Pupil-dilated; 2228 x 1652 pixels:
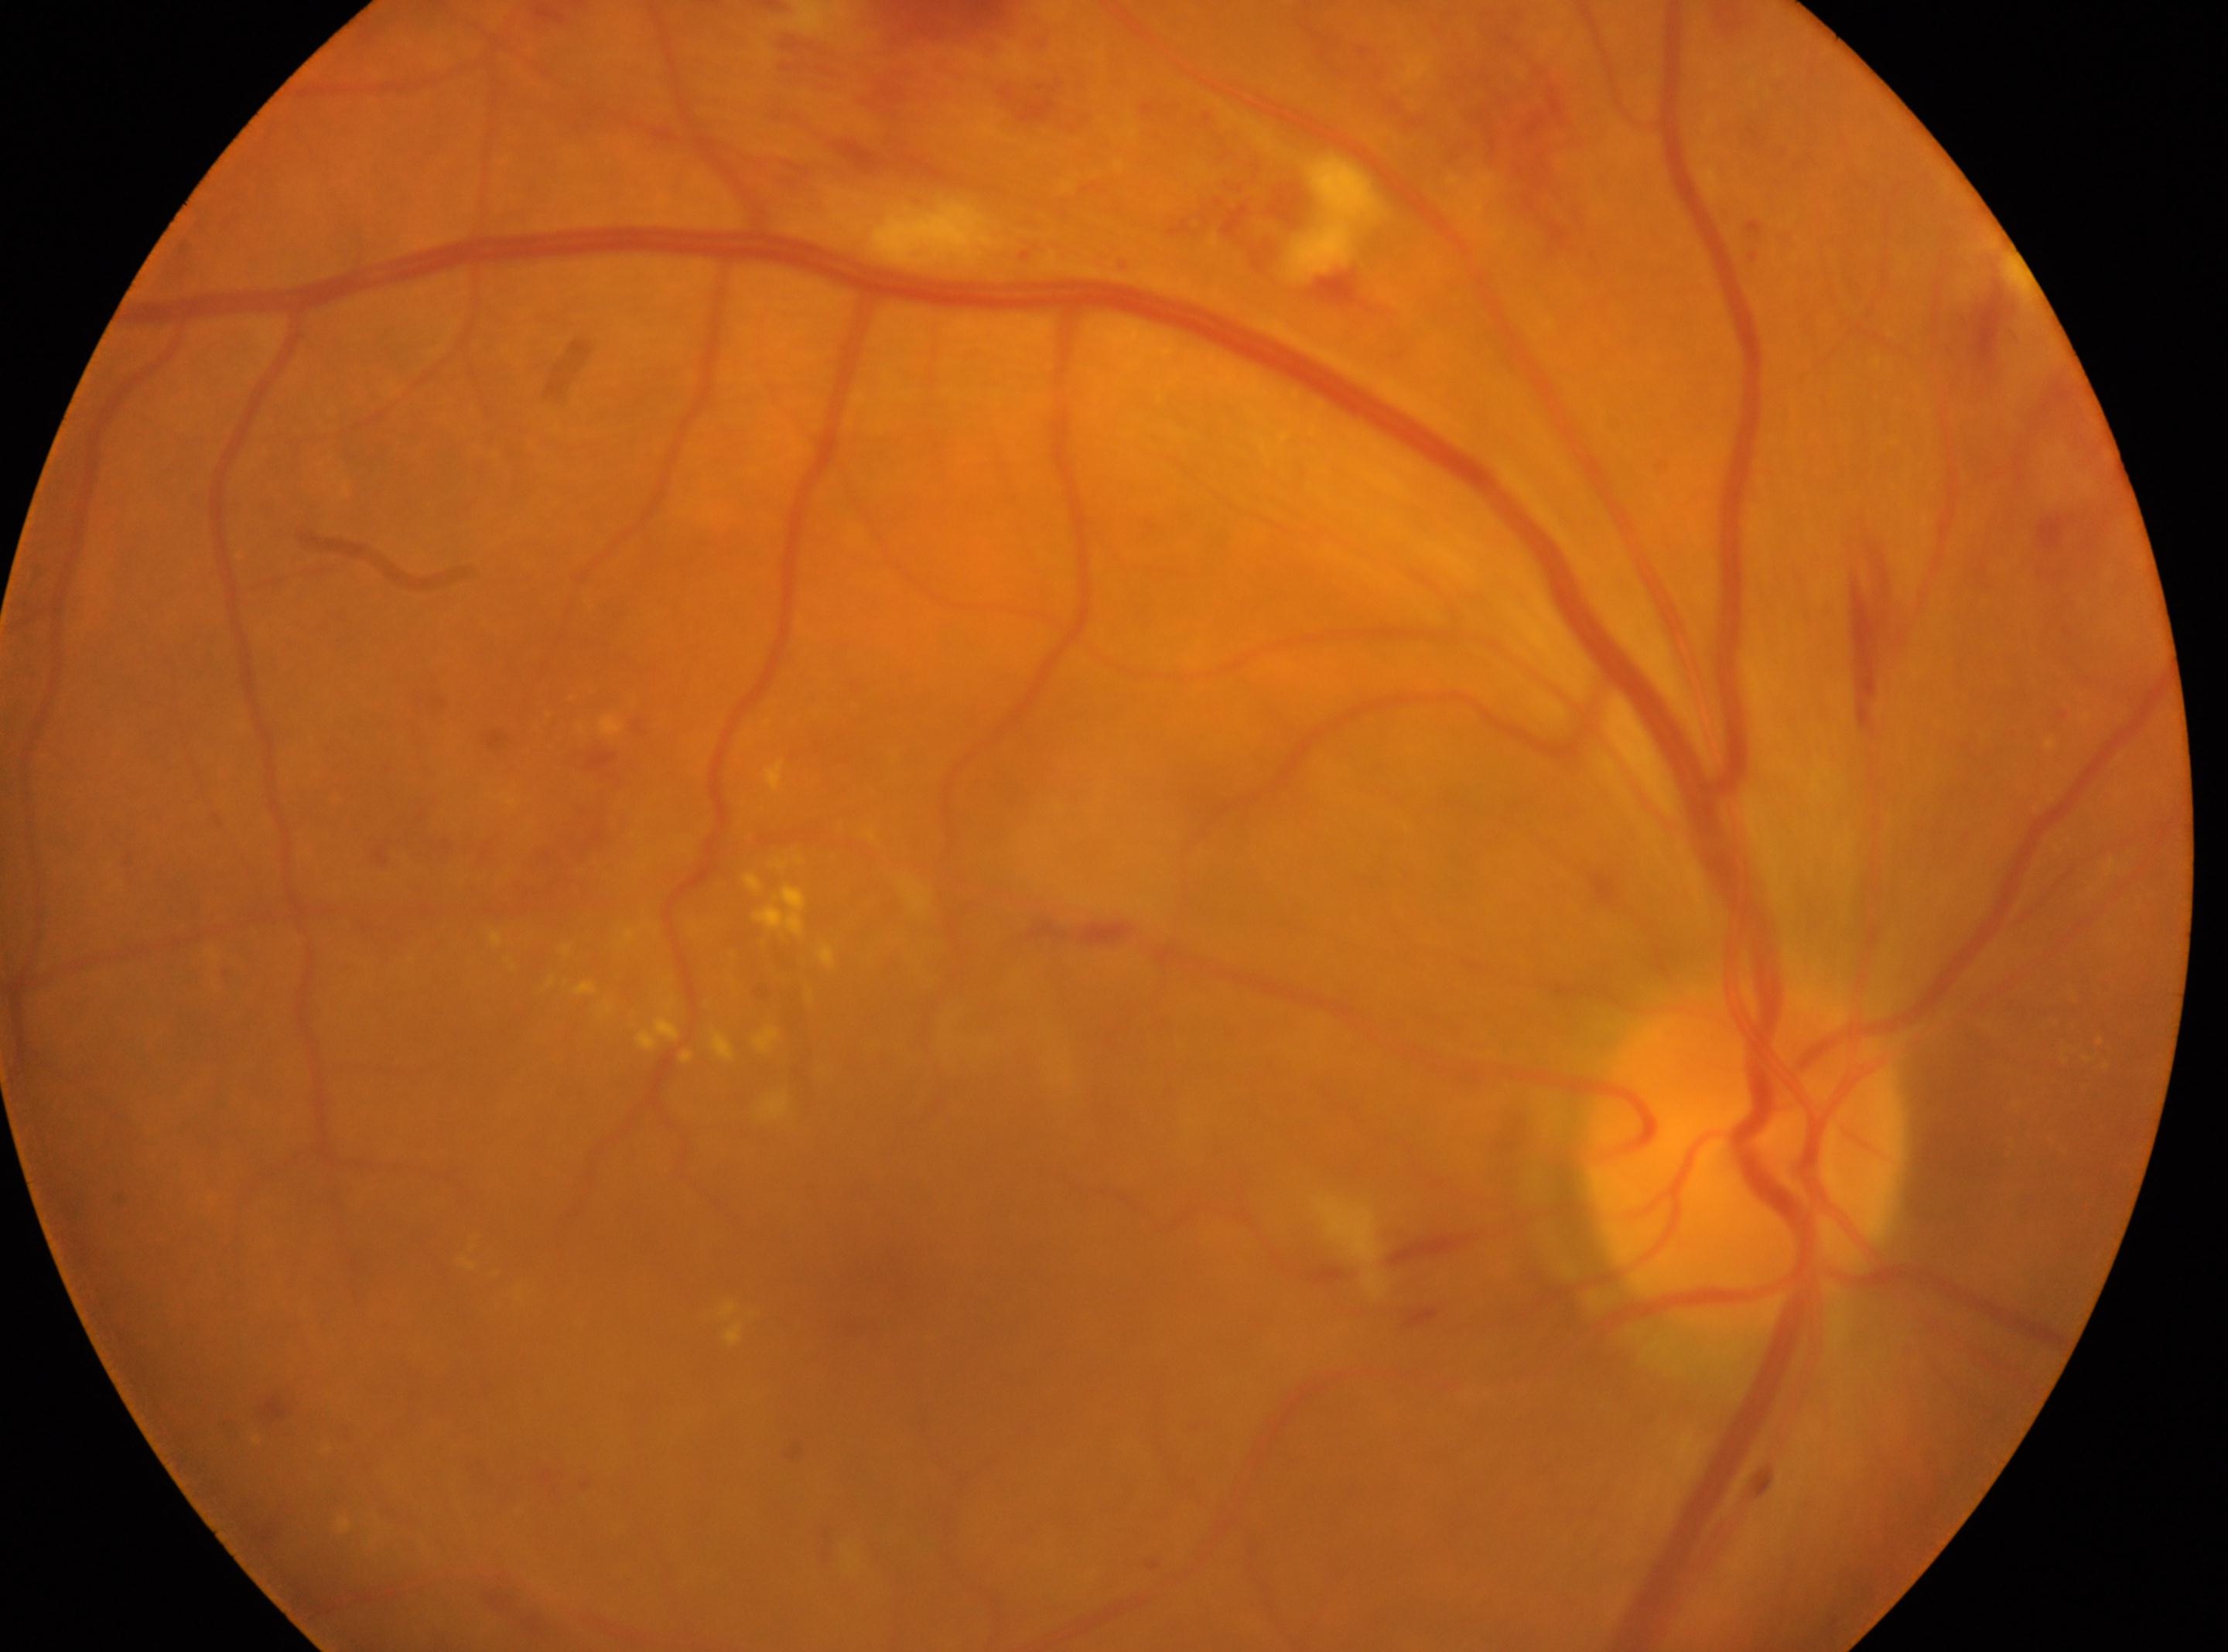

The ONH is at 1748px, 1154px. Diabetic retinopathy is moderate NPDR (grade 2). Fovea center located at 856px, 1288px. This is the OD.